Color fundus image: 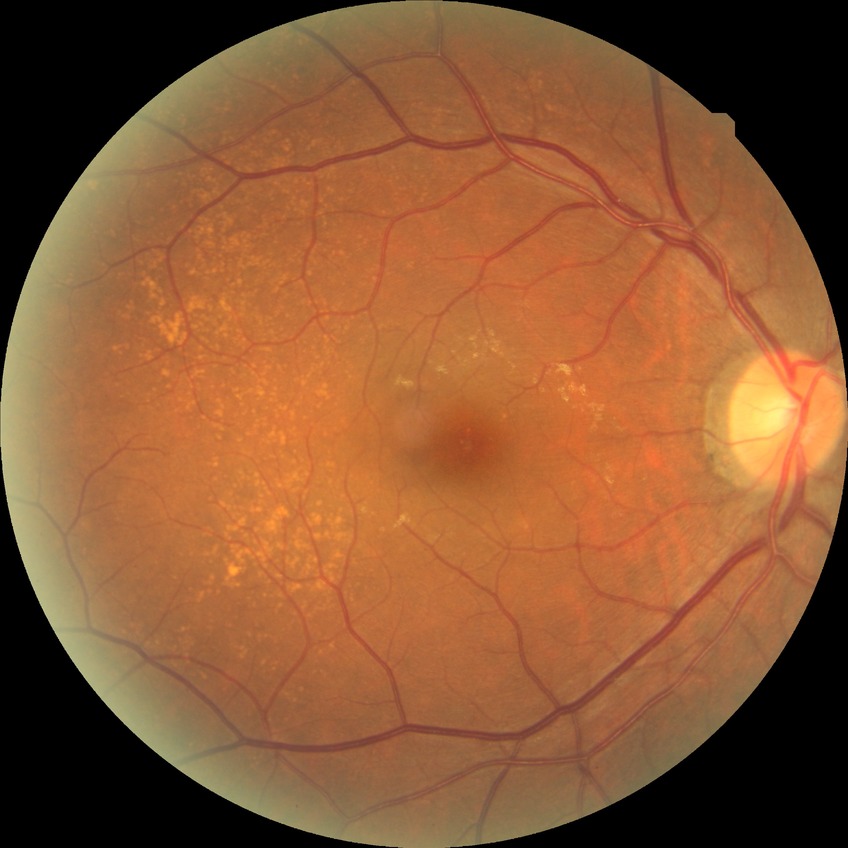 Diabetic retinopathy (DR) is no diabetic retinopathy (NDR).